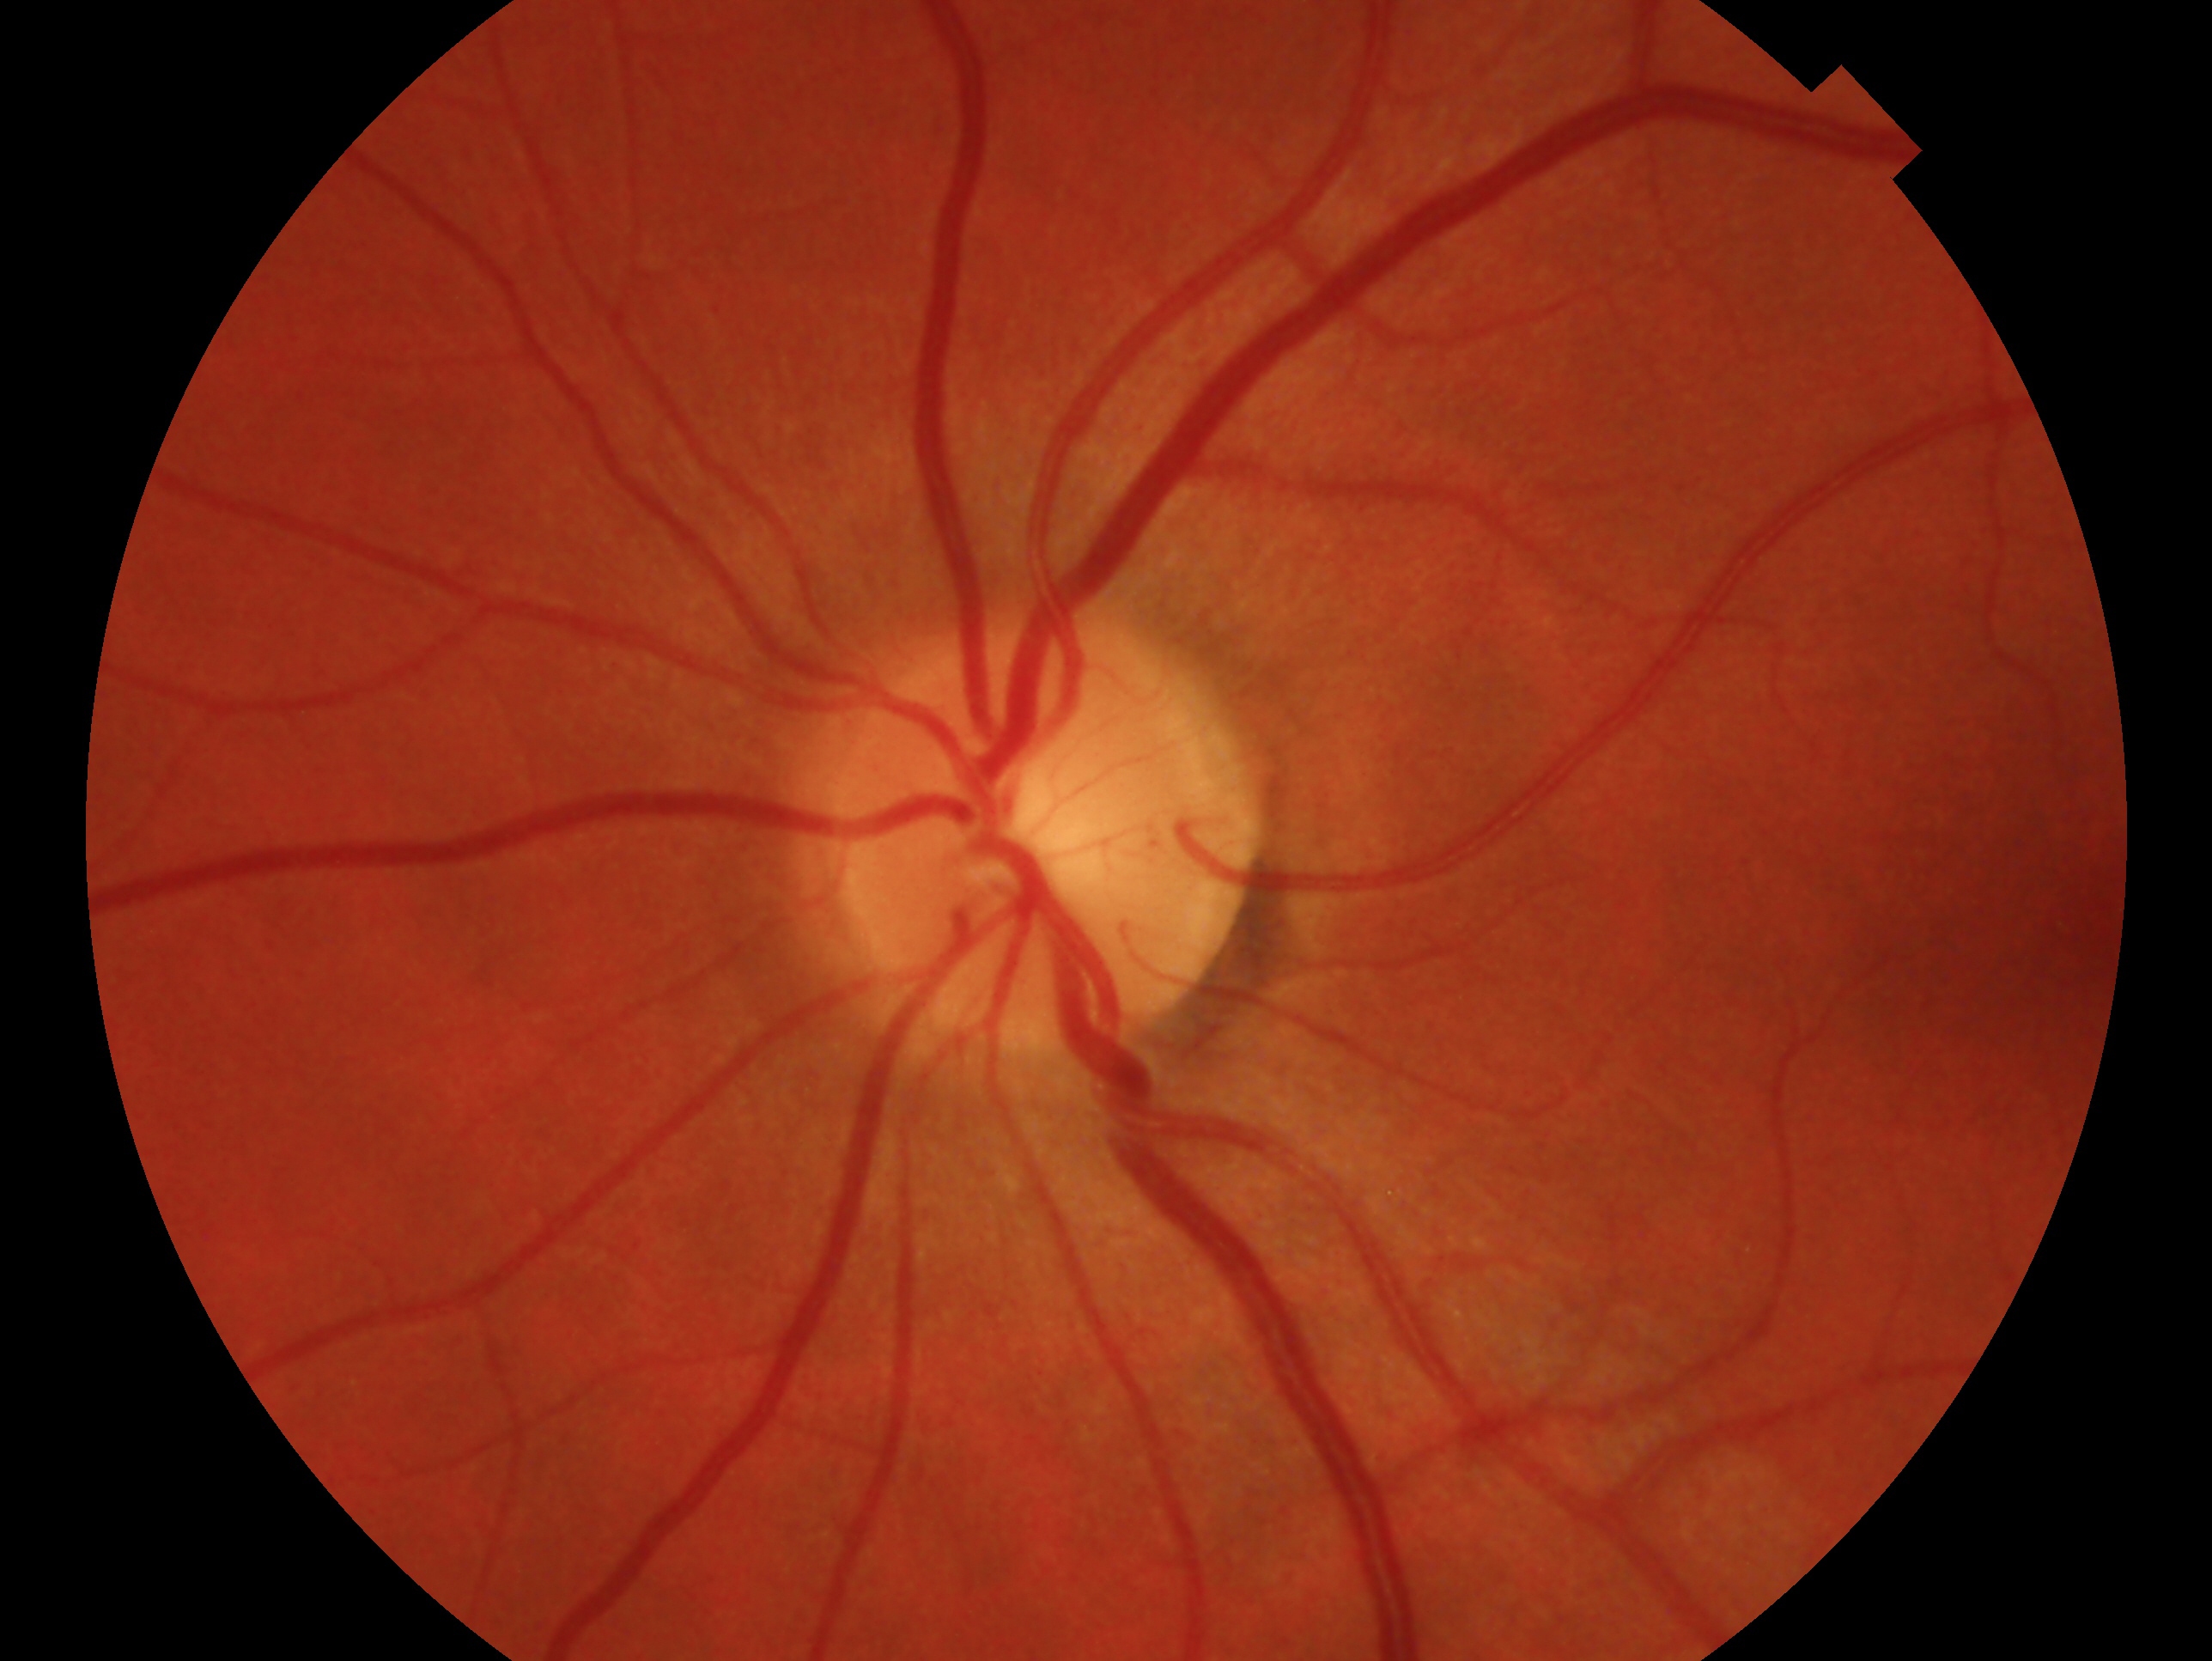 This is the left eye. Impression — no evidence of glaucoma.